CFP: 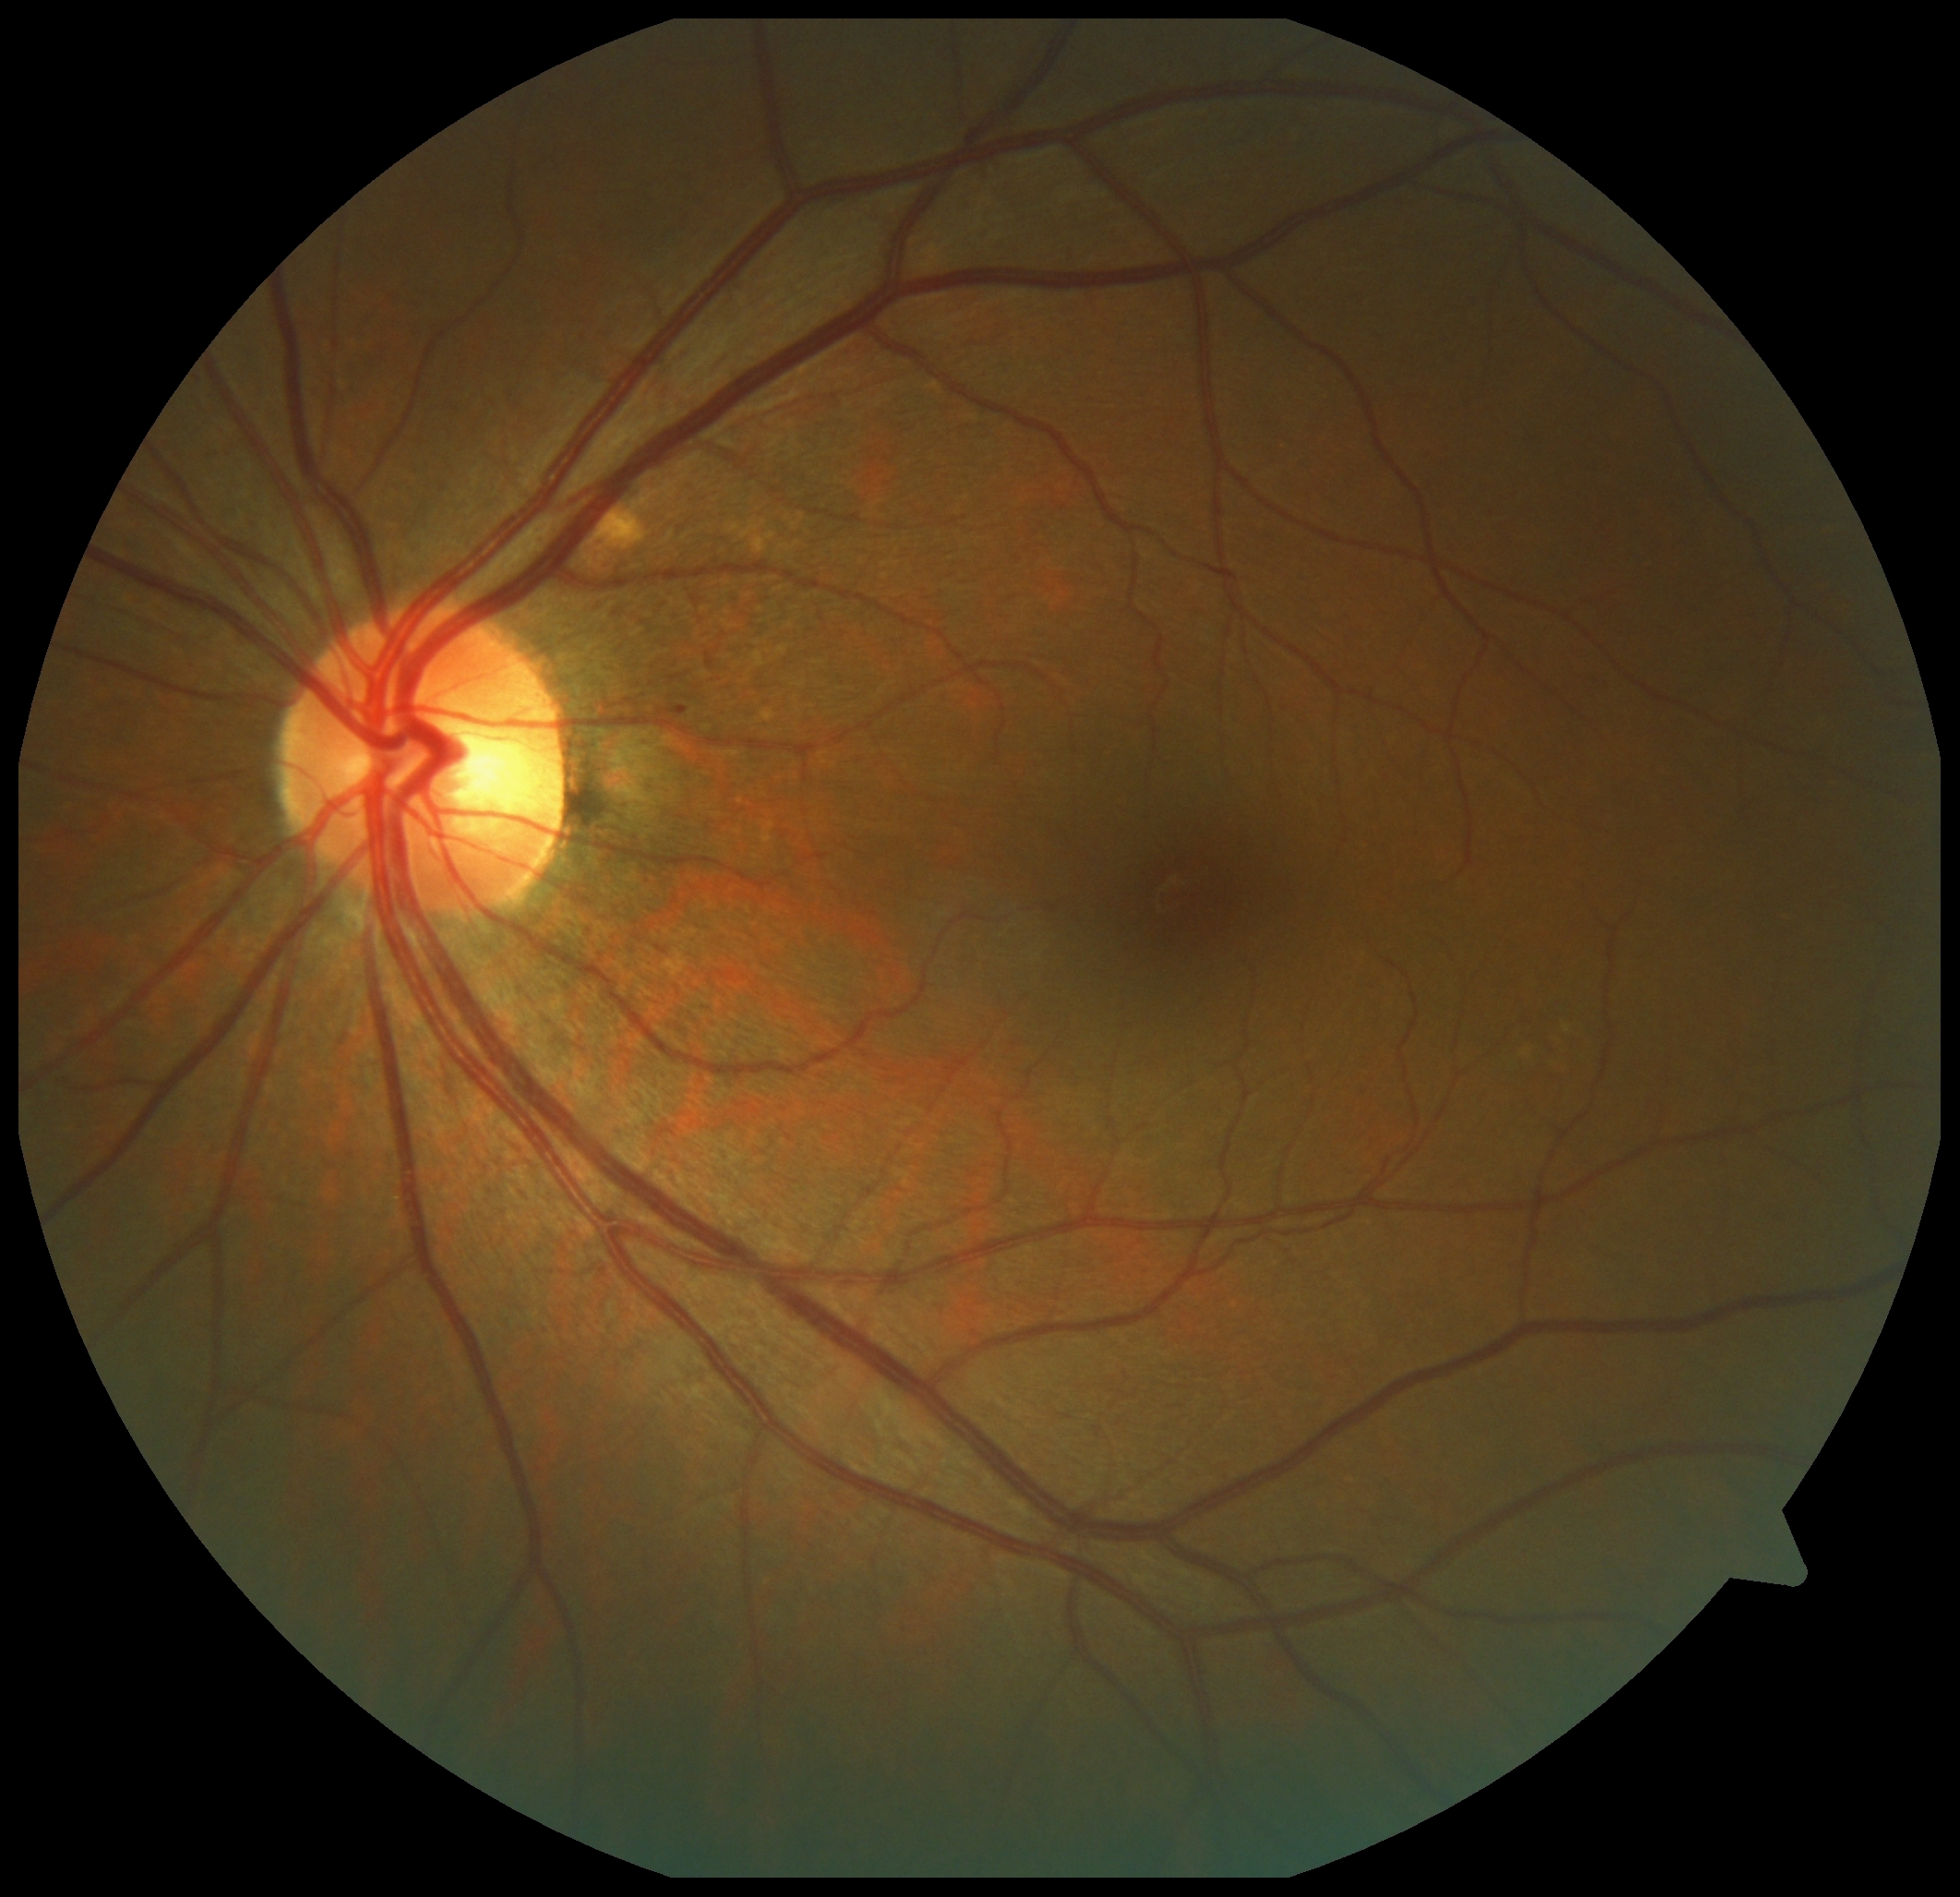
DR stage is grade 1 (mild NPDR).